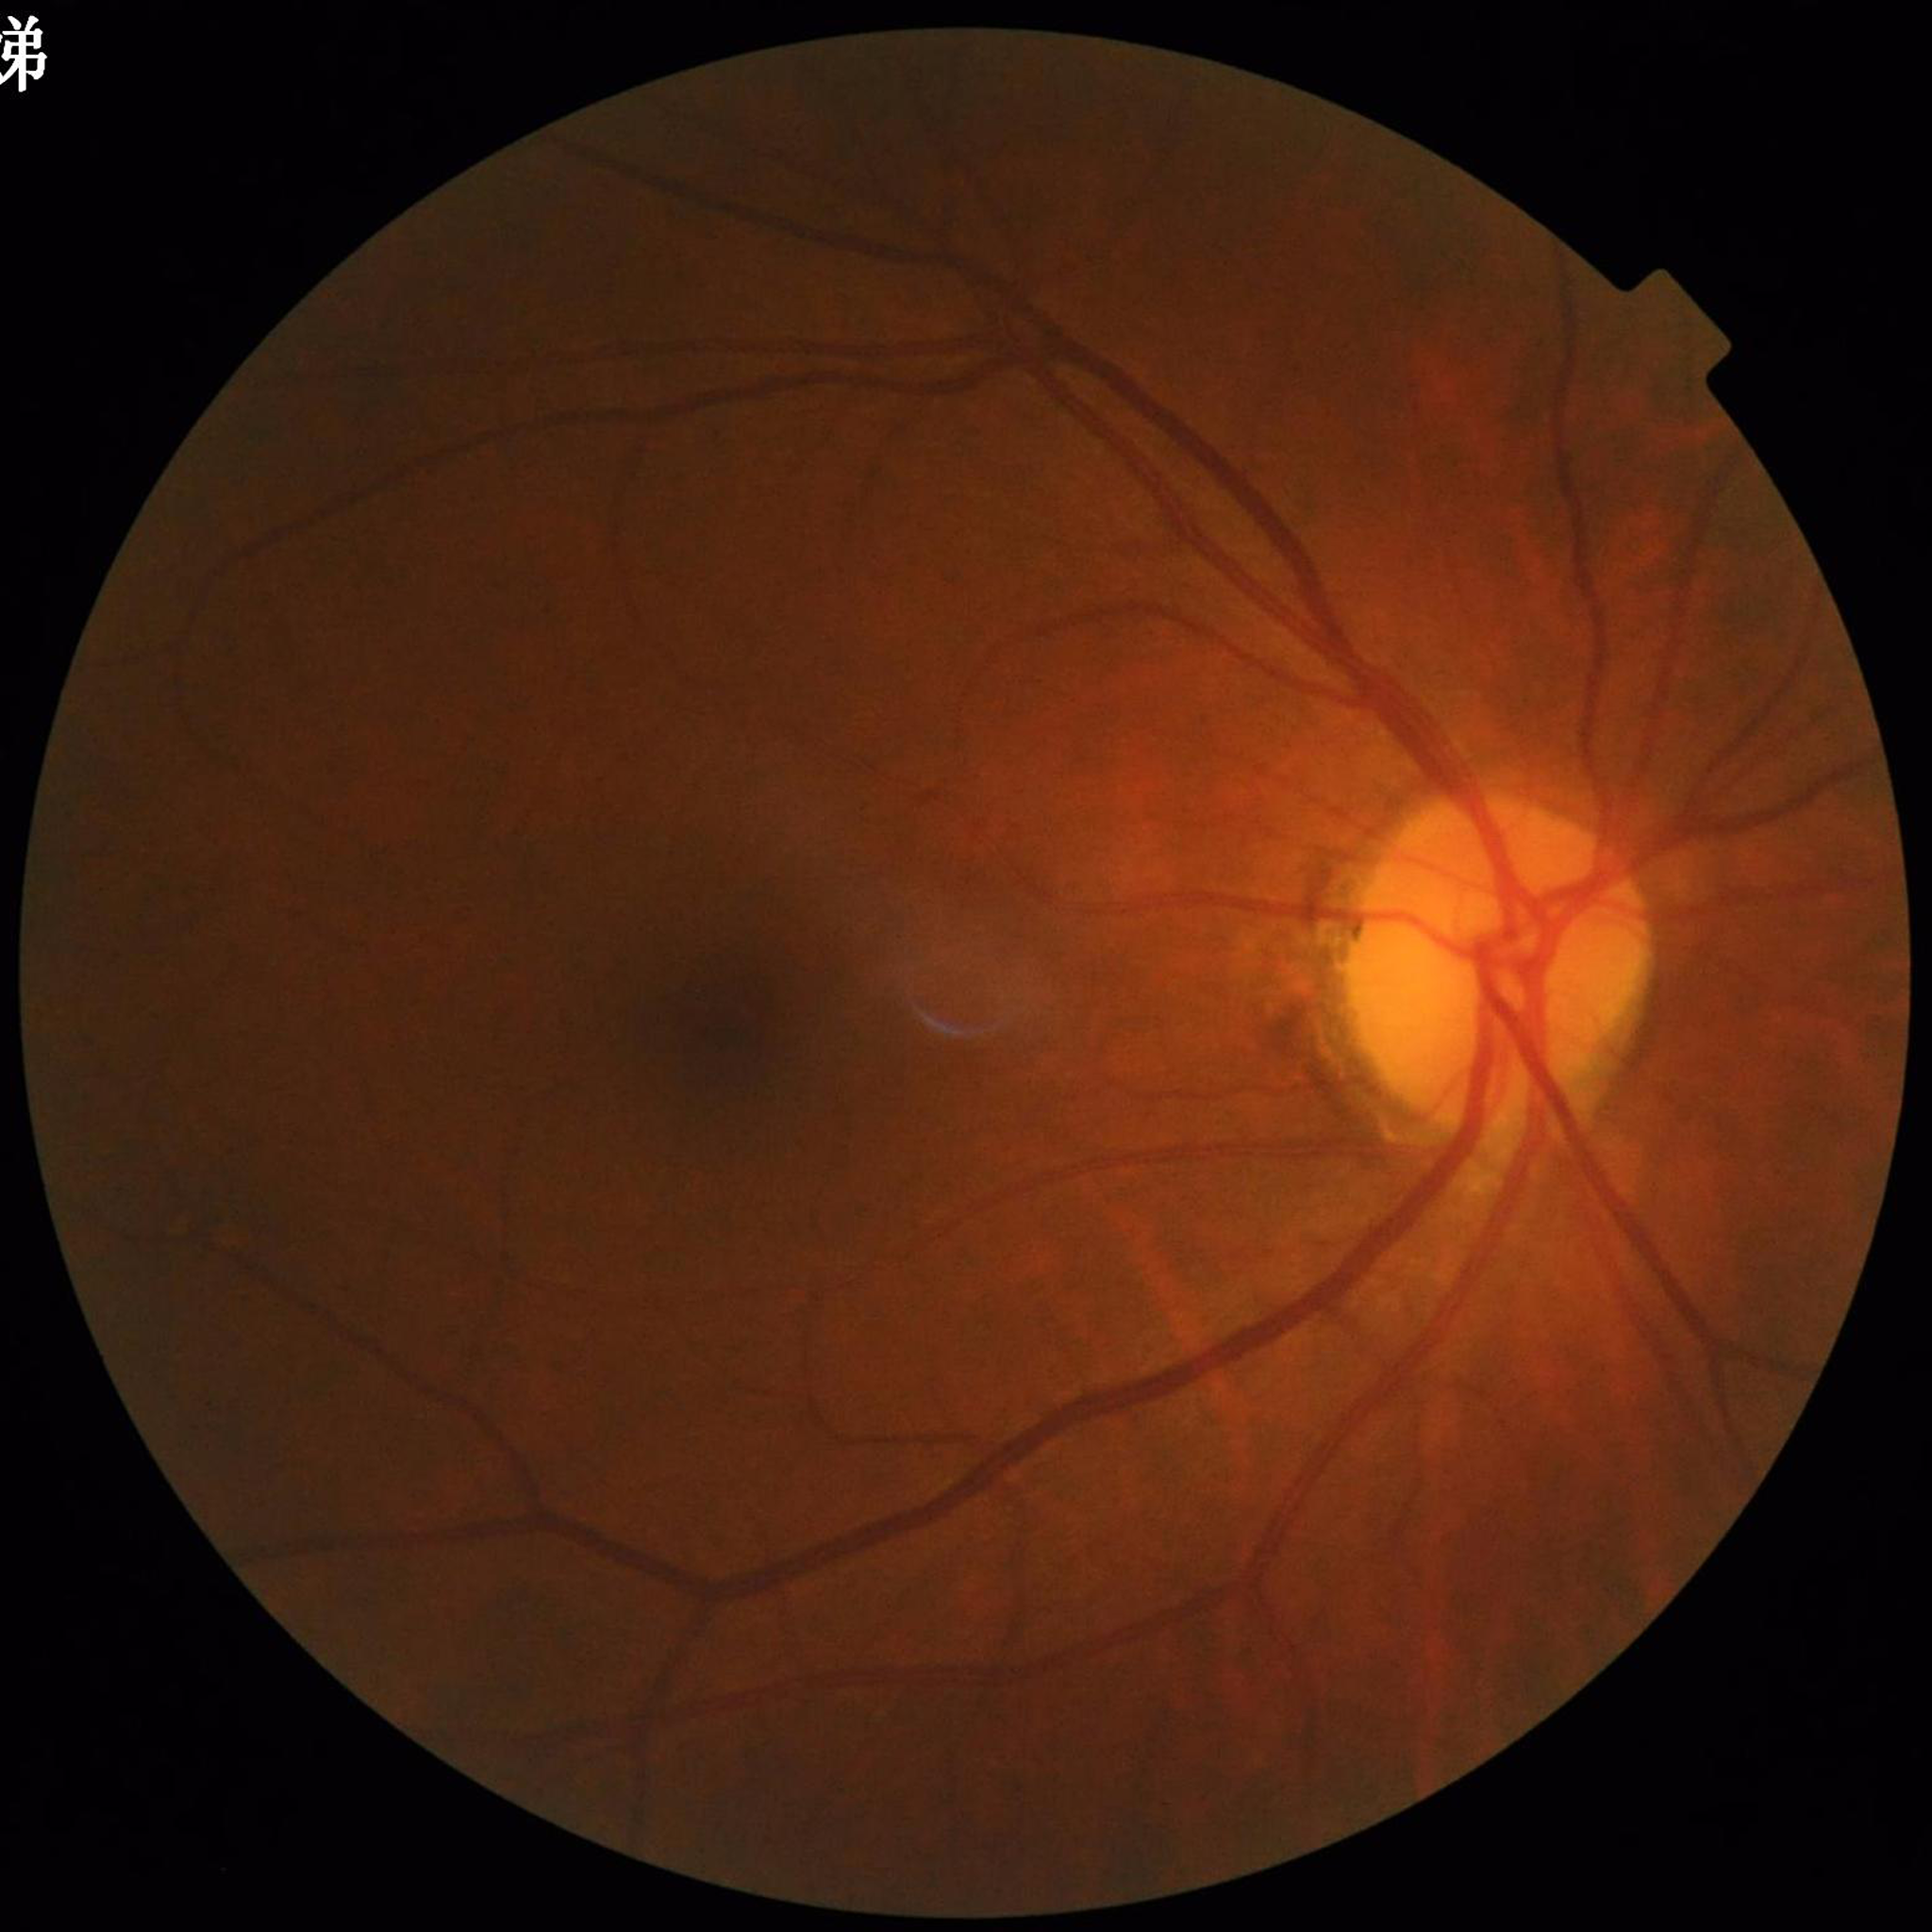 From a patient with glaucoma.
Quality assessment: contrast adequate, illumination and color satisfactory, no blur.